Ultra-widefield (UWF) fundus image. 1924x1556px:
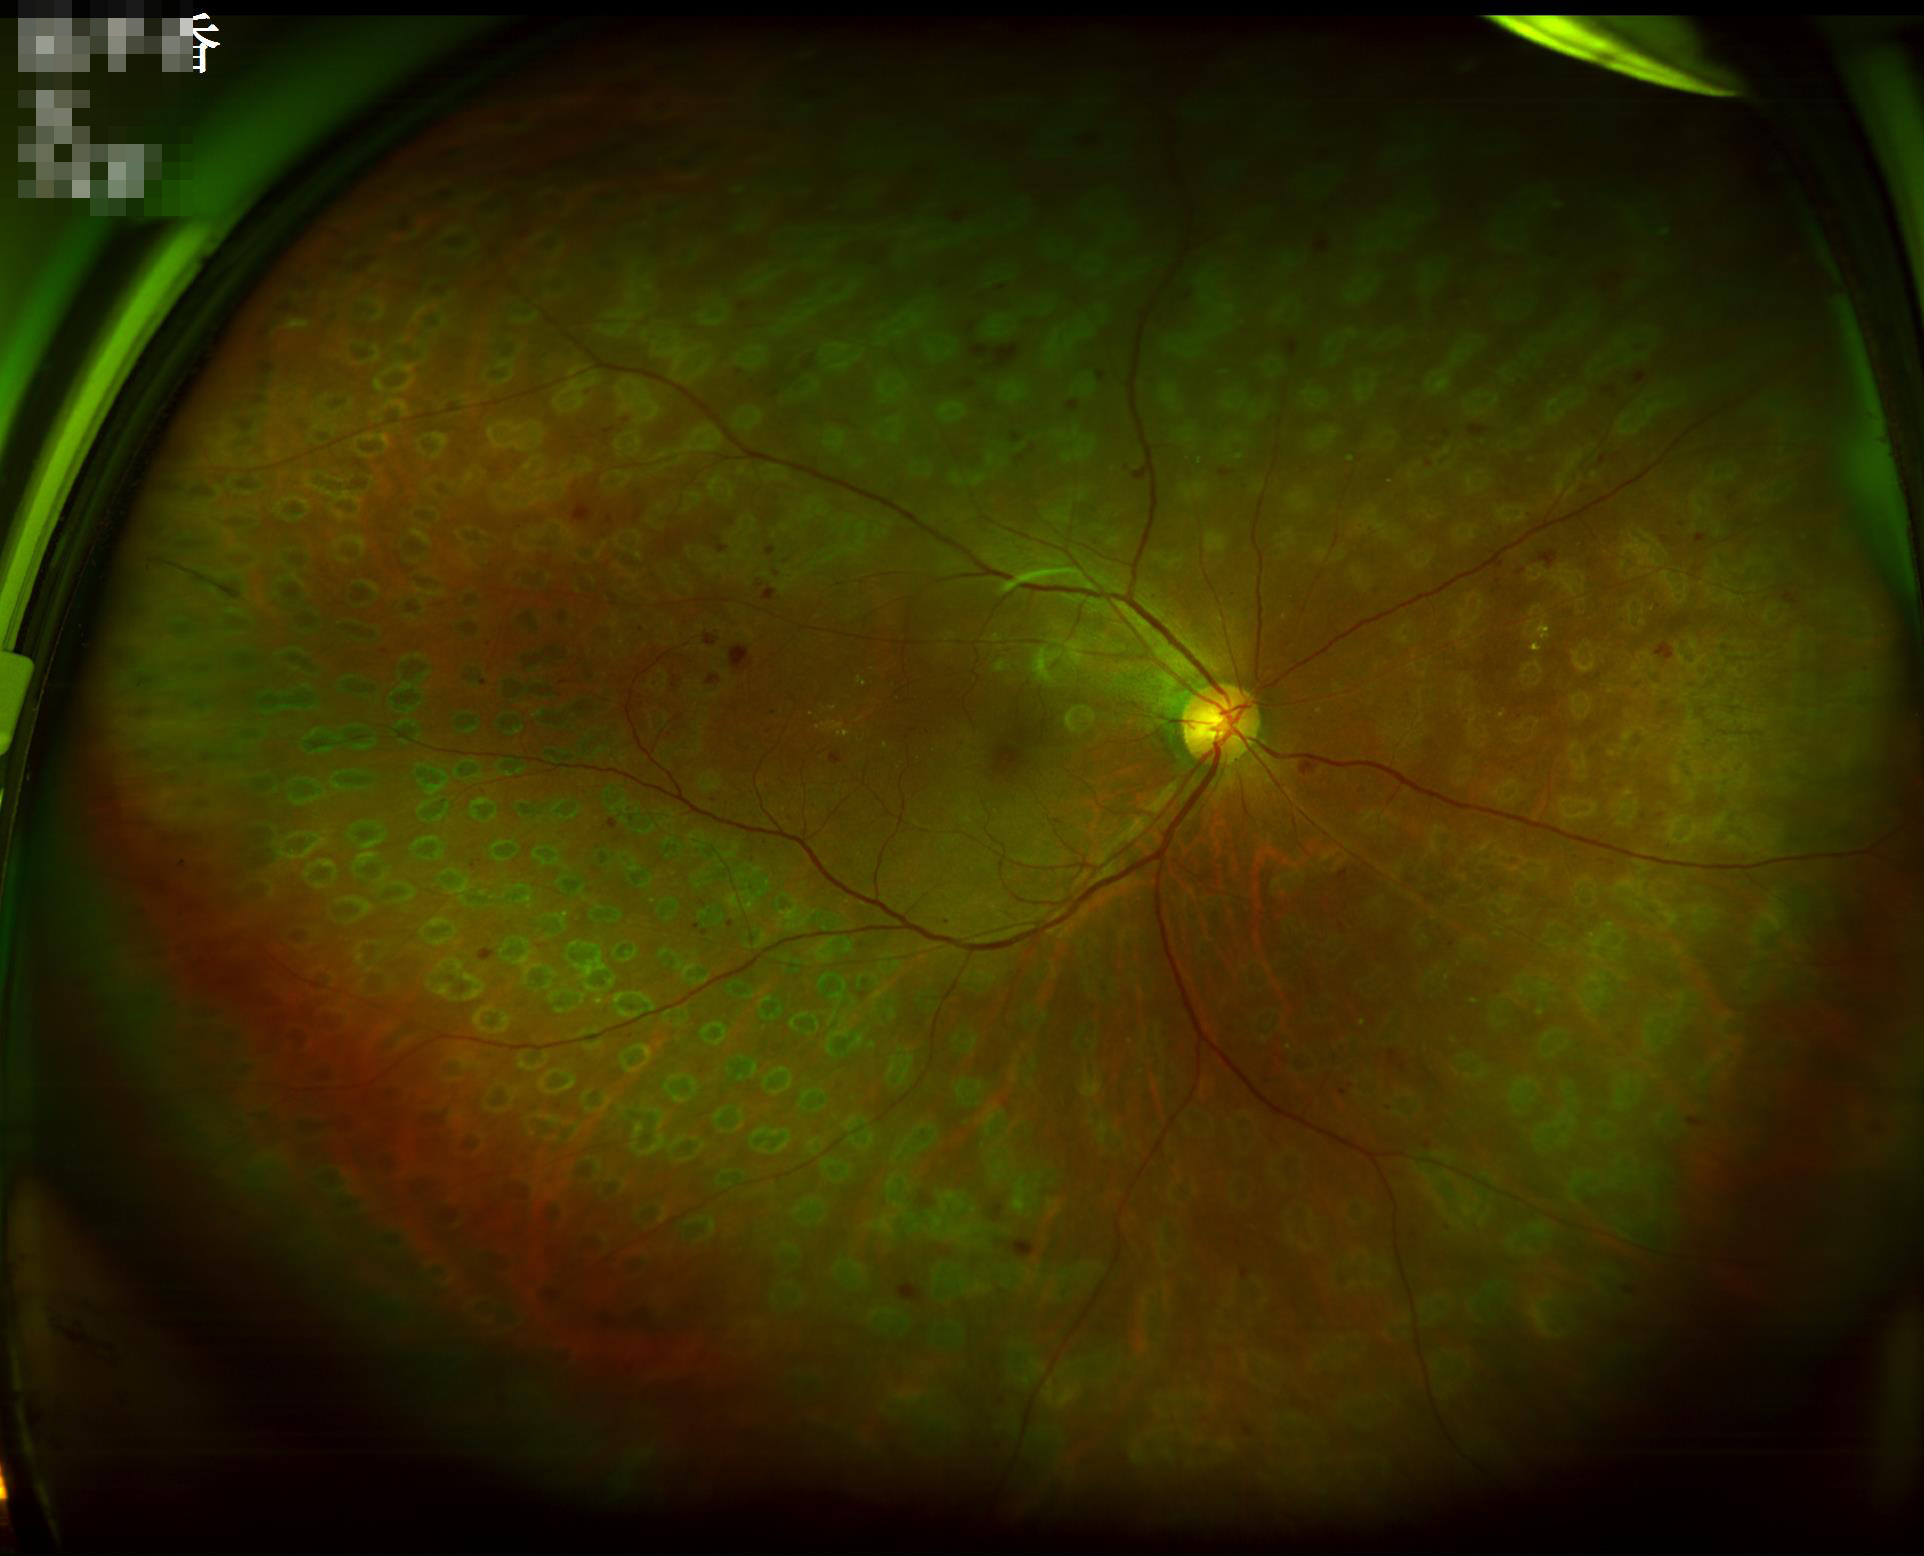
  contrast: good
  clarity: clear
  illumination: even
  overall_quality: acceptable